Davis DR grading: 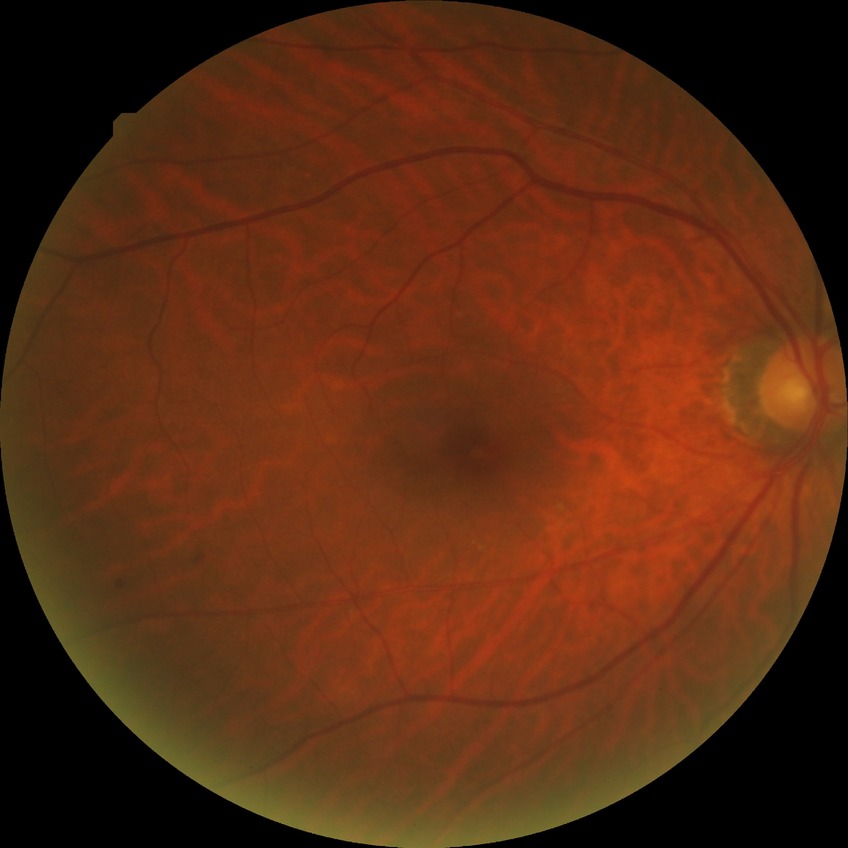
Retinopathy stage: simple diabetic retinopathy.